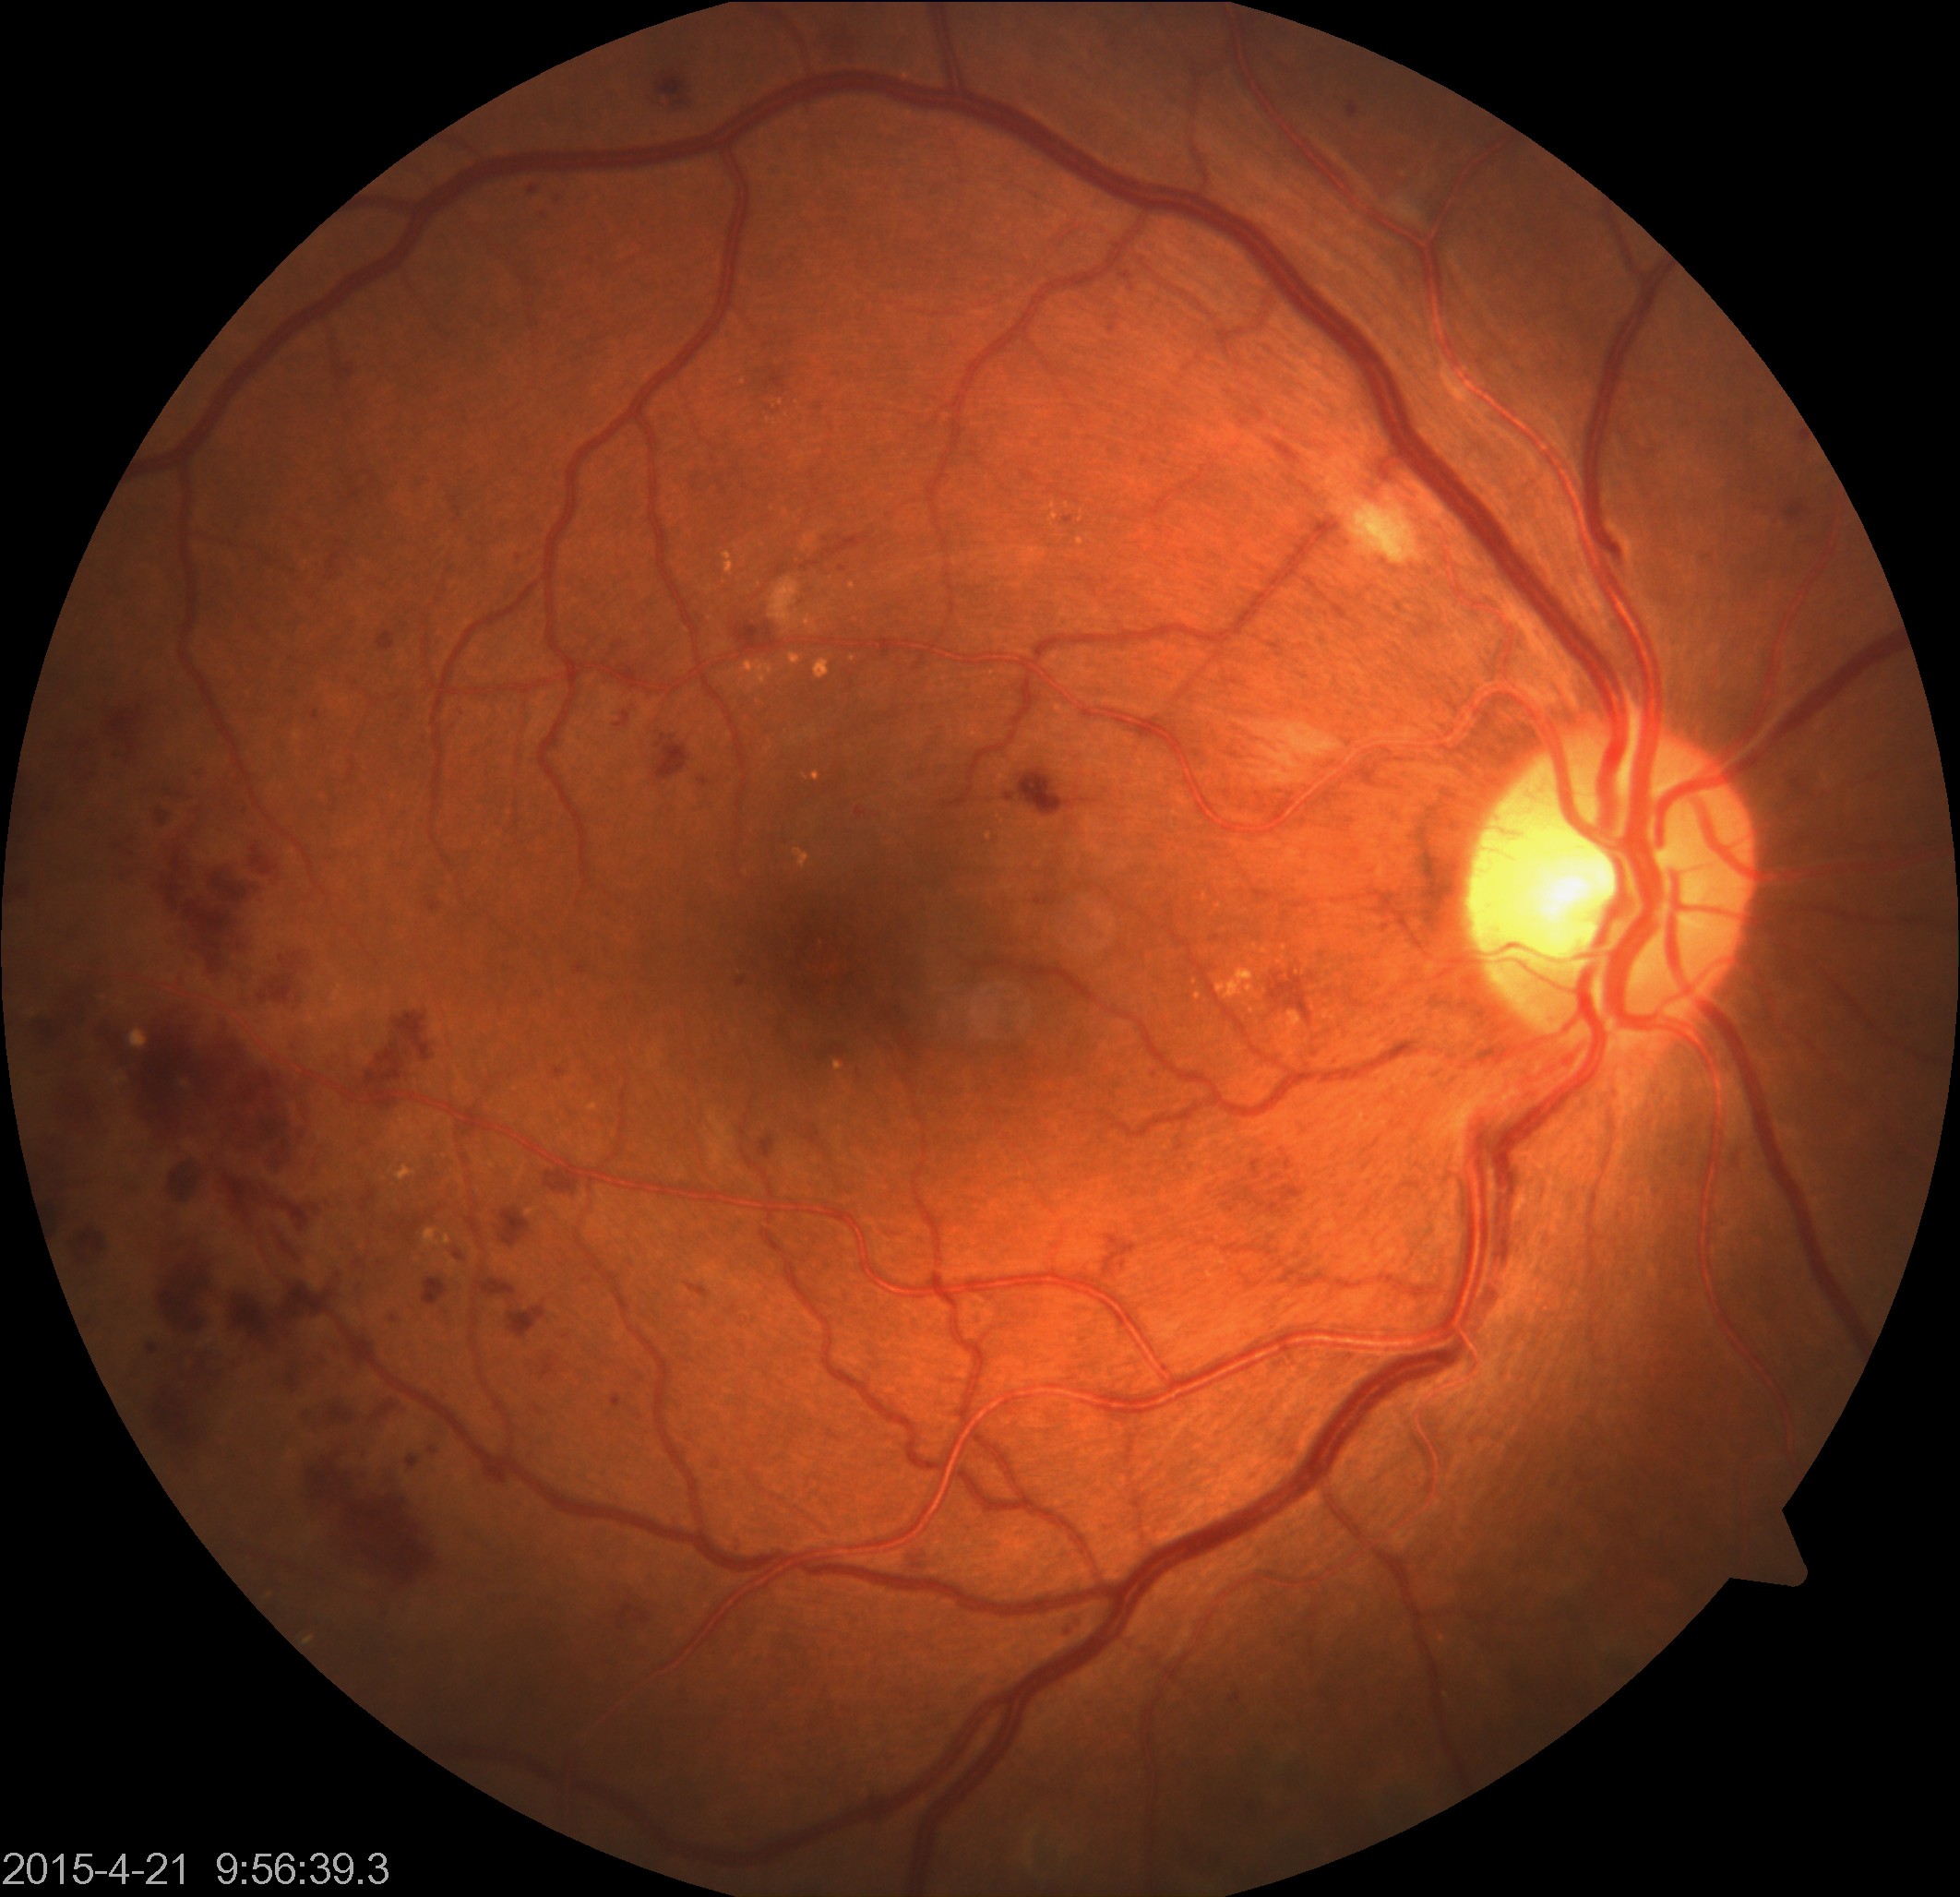
Fundus appearance consistent with moderate non-proliferative diabetic retinopathy.